Graded on the modified Davis scale, posterior pole color fundus photograph: 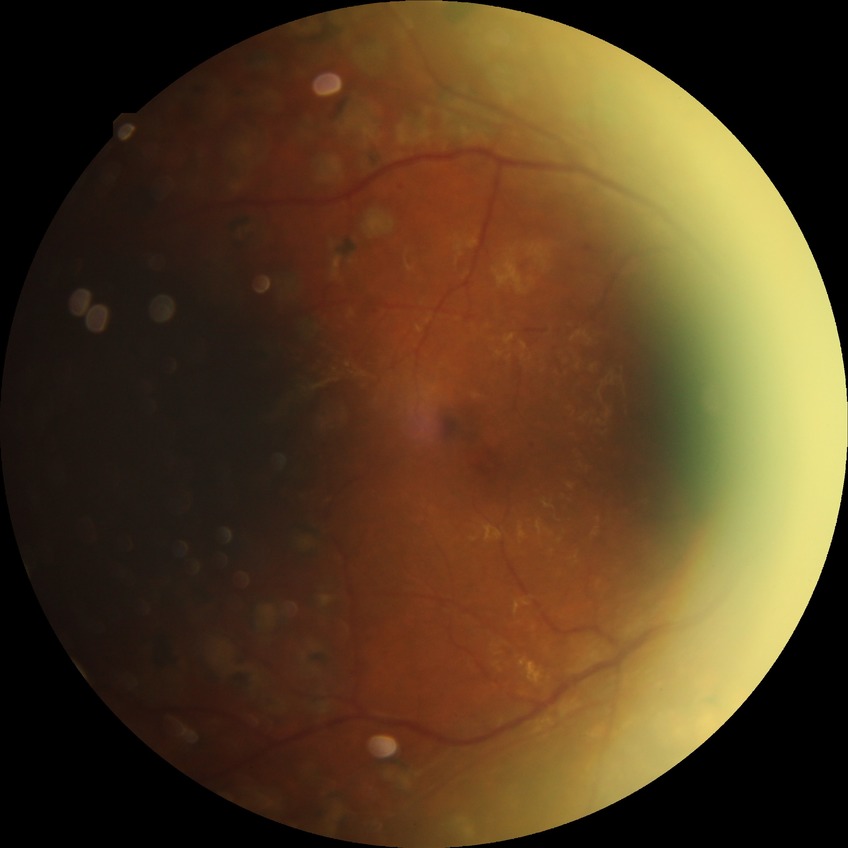

Diabetic retinopathy (DR): PDR (proliferative diabetic retinopathy).